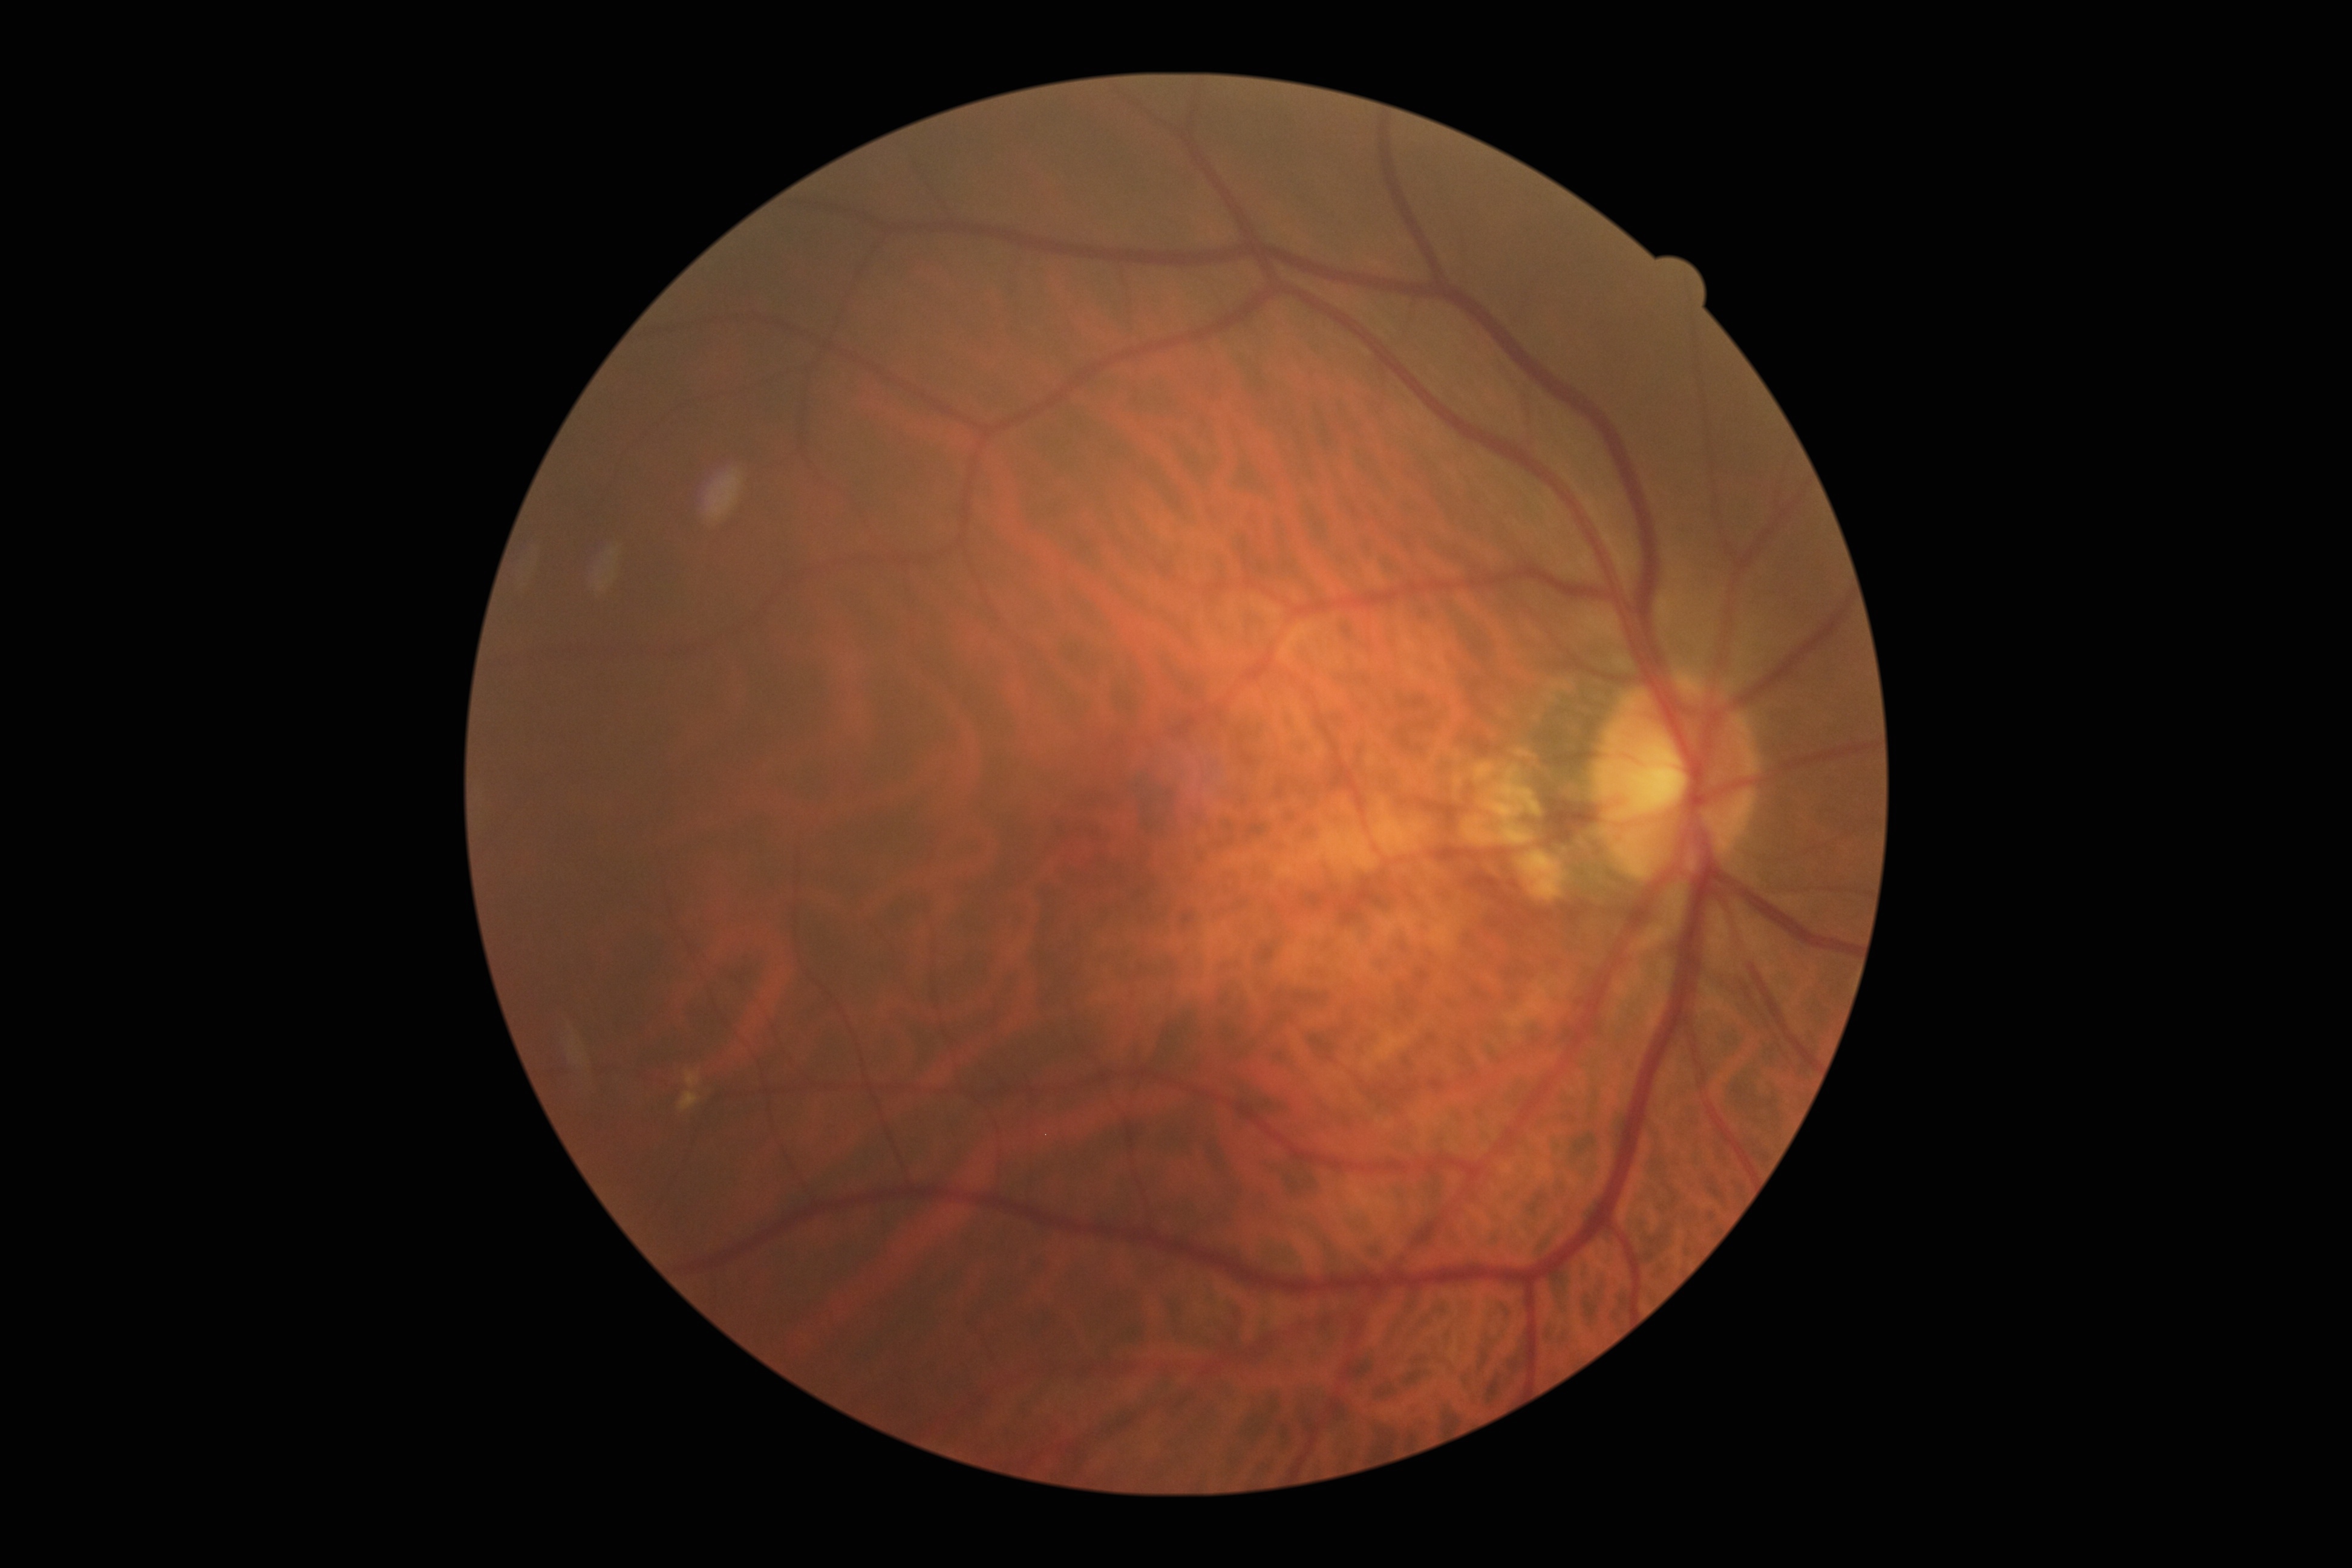 No diabetic retinal disease findings. Retinopathy is 0.